Graded on the modified Davis scale · camera: NIDEK AFC-230 · without pupil dilation.
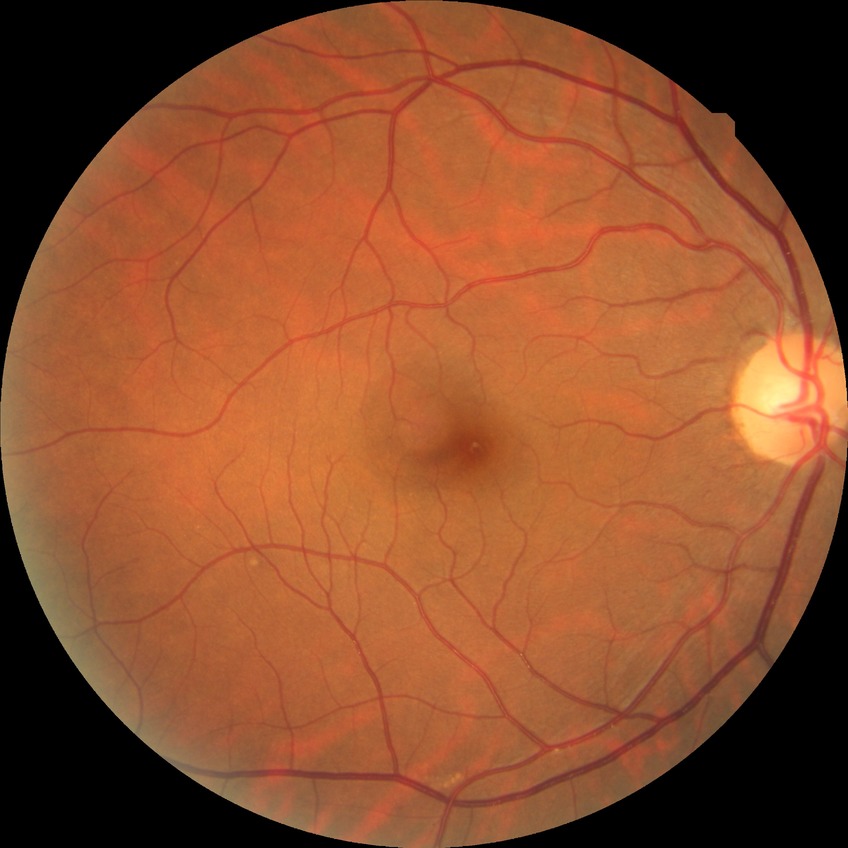 Diabetic retinopathy (DR) is no diabetic retinopathy (NDR).